NIDEK AFC-230: 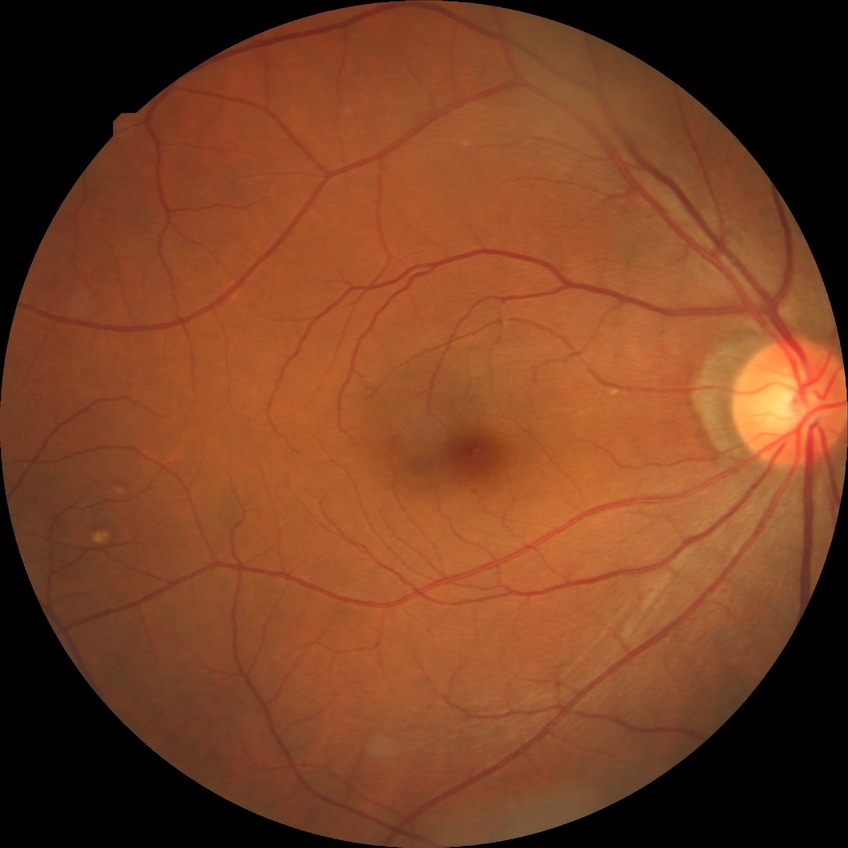

diabetic retinopathy (DR)@no diabetic retinopathy (NDR).